Camera: Phoenix ICON (100° FOV). 1240x1240. Wide-field fundus image from infant ROP screening.
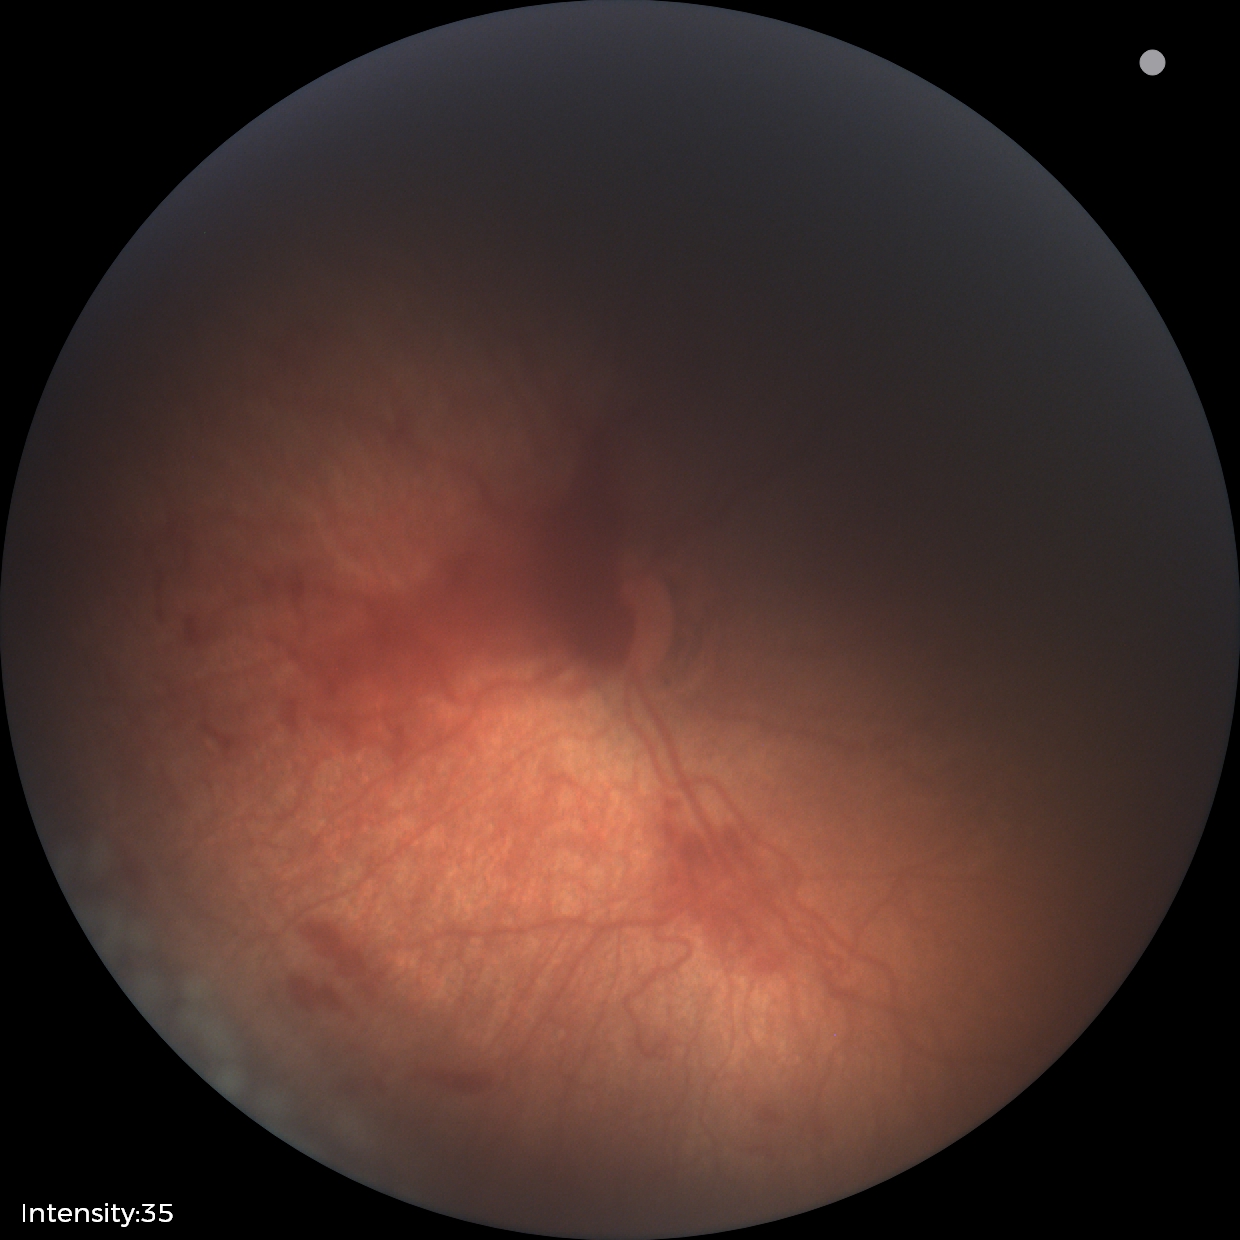

Screening examination consistent with ROP stage 2.